CFP — 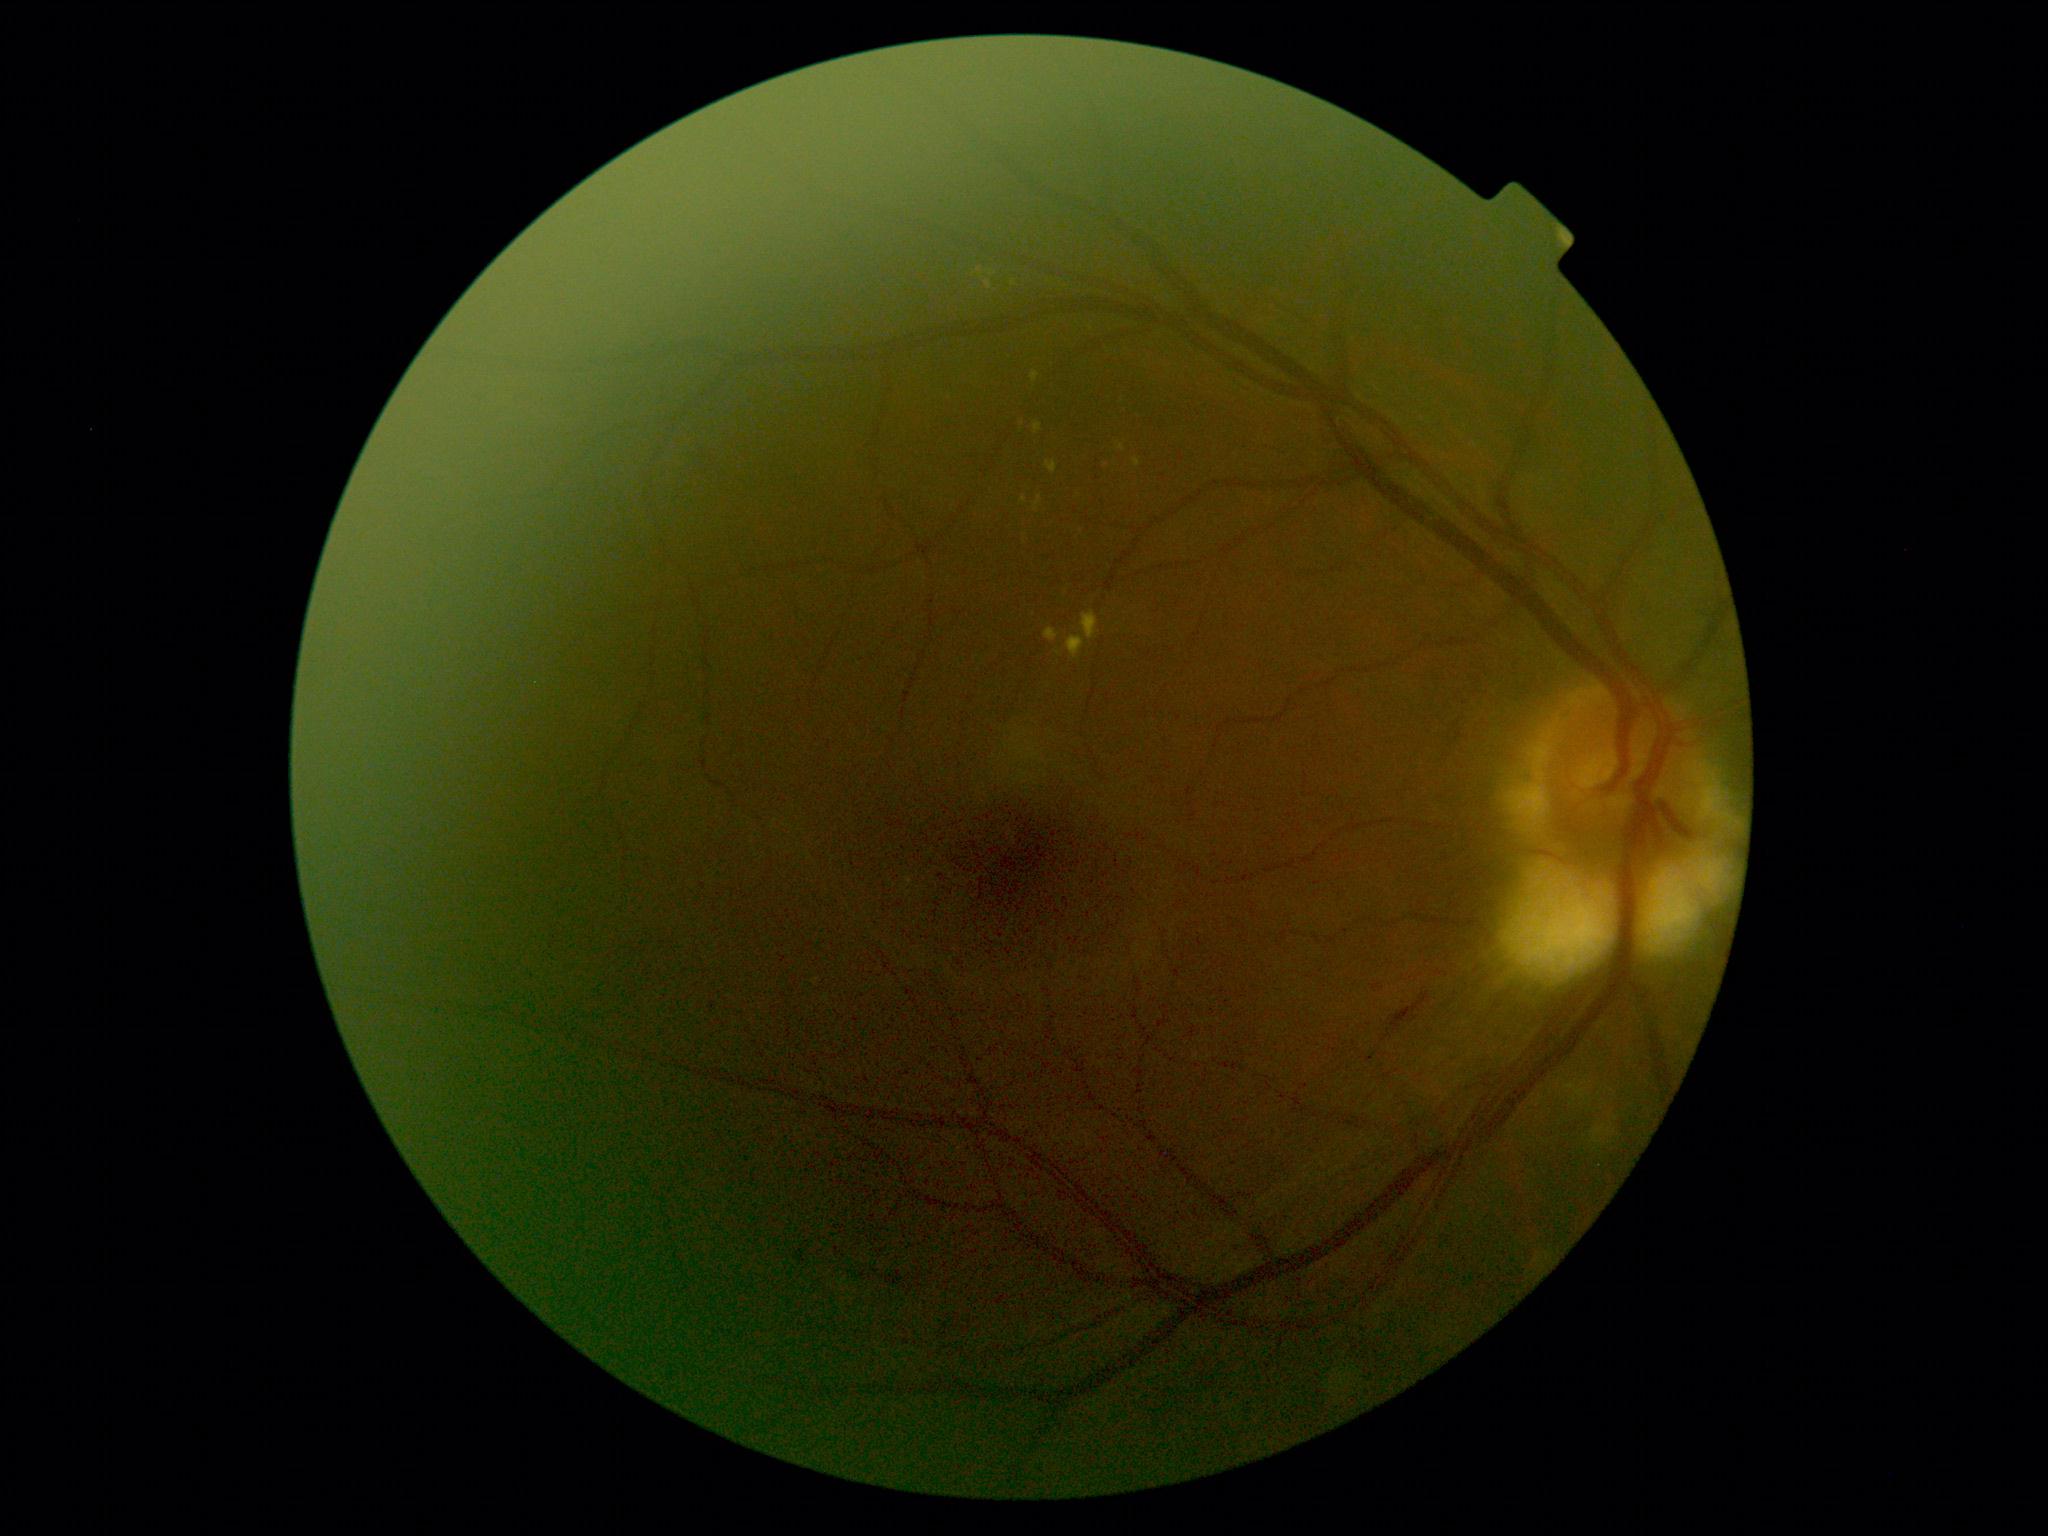

DR class = non-proliferative diabetic retinopathy | diabetic retinopathy (DR) = 2 — more than just microaneurysms but less than severe NPDR.